45-degree field of view: 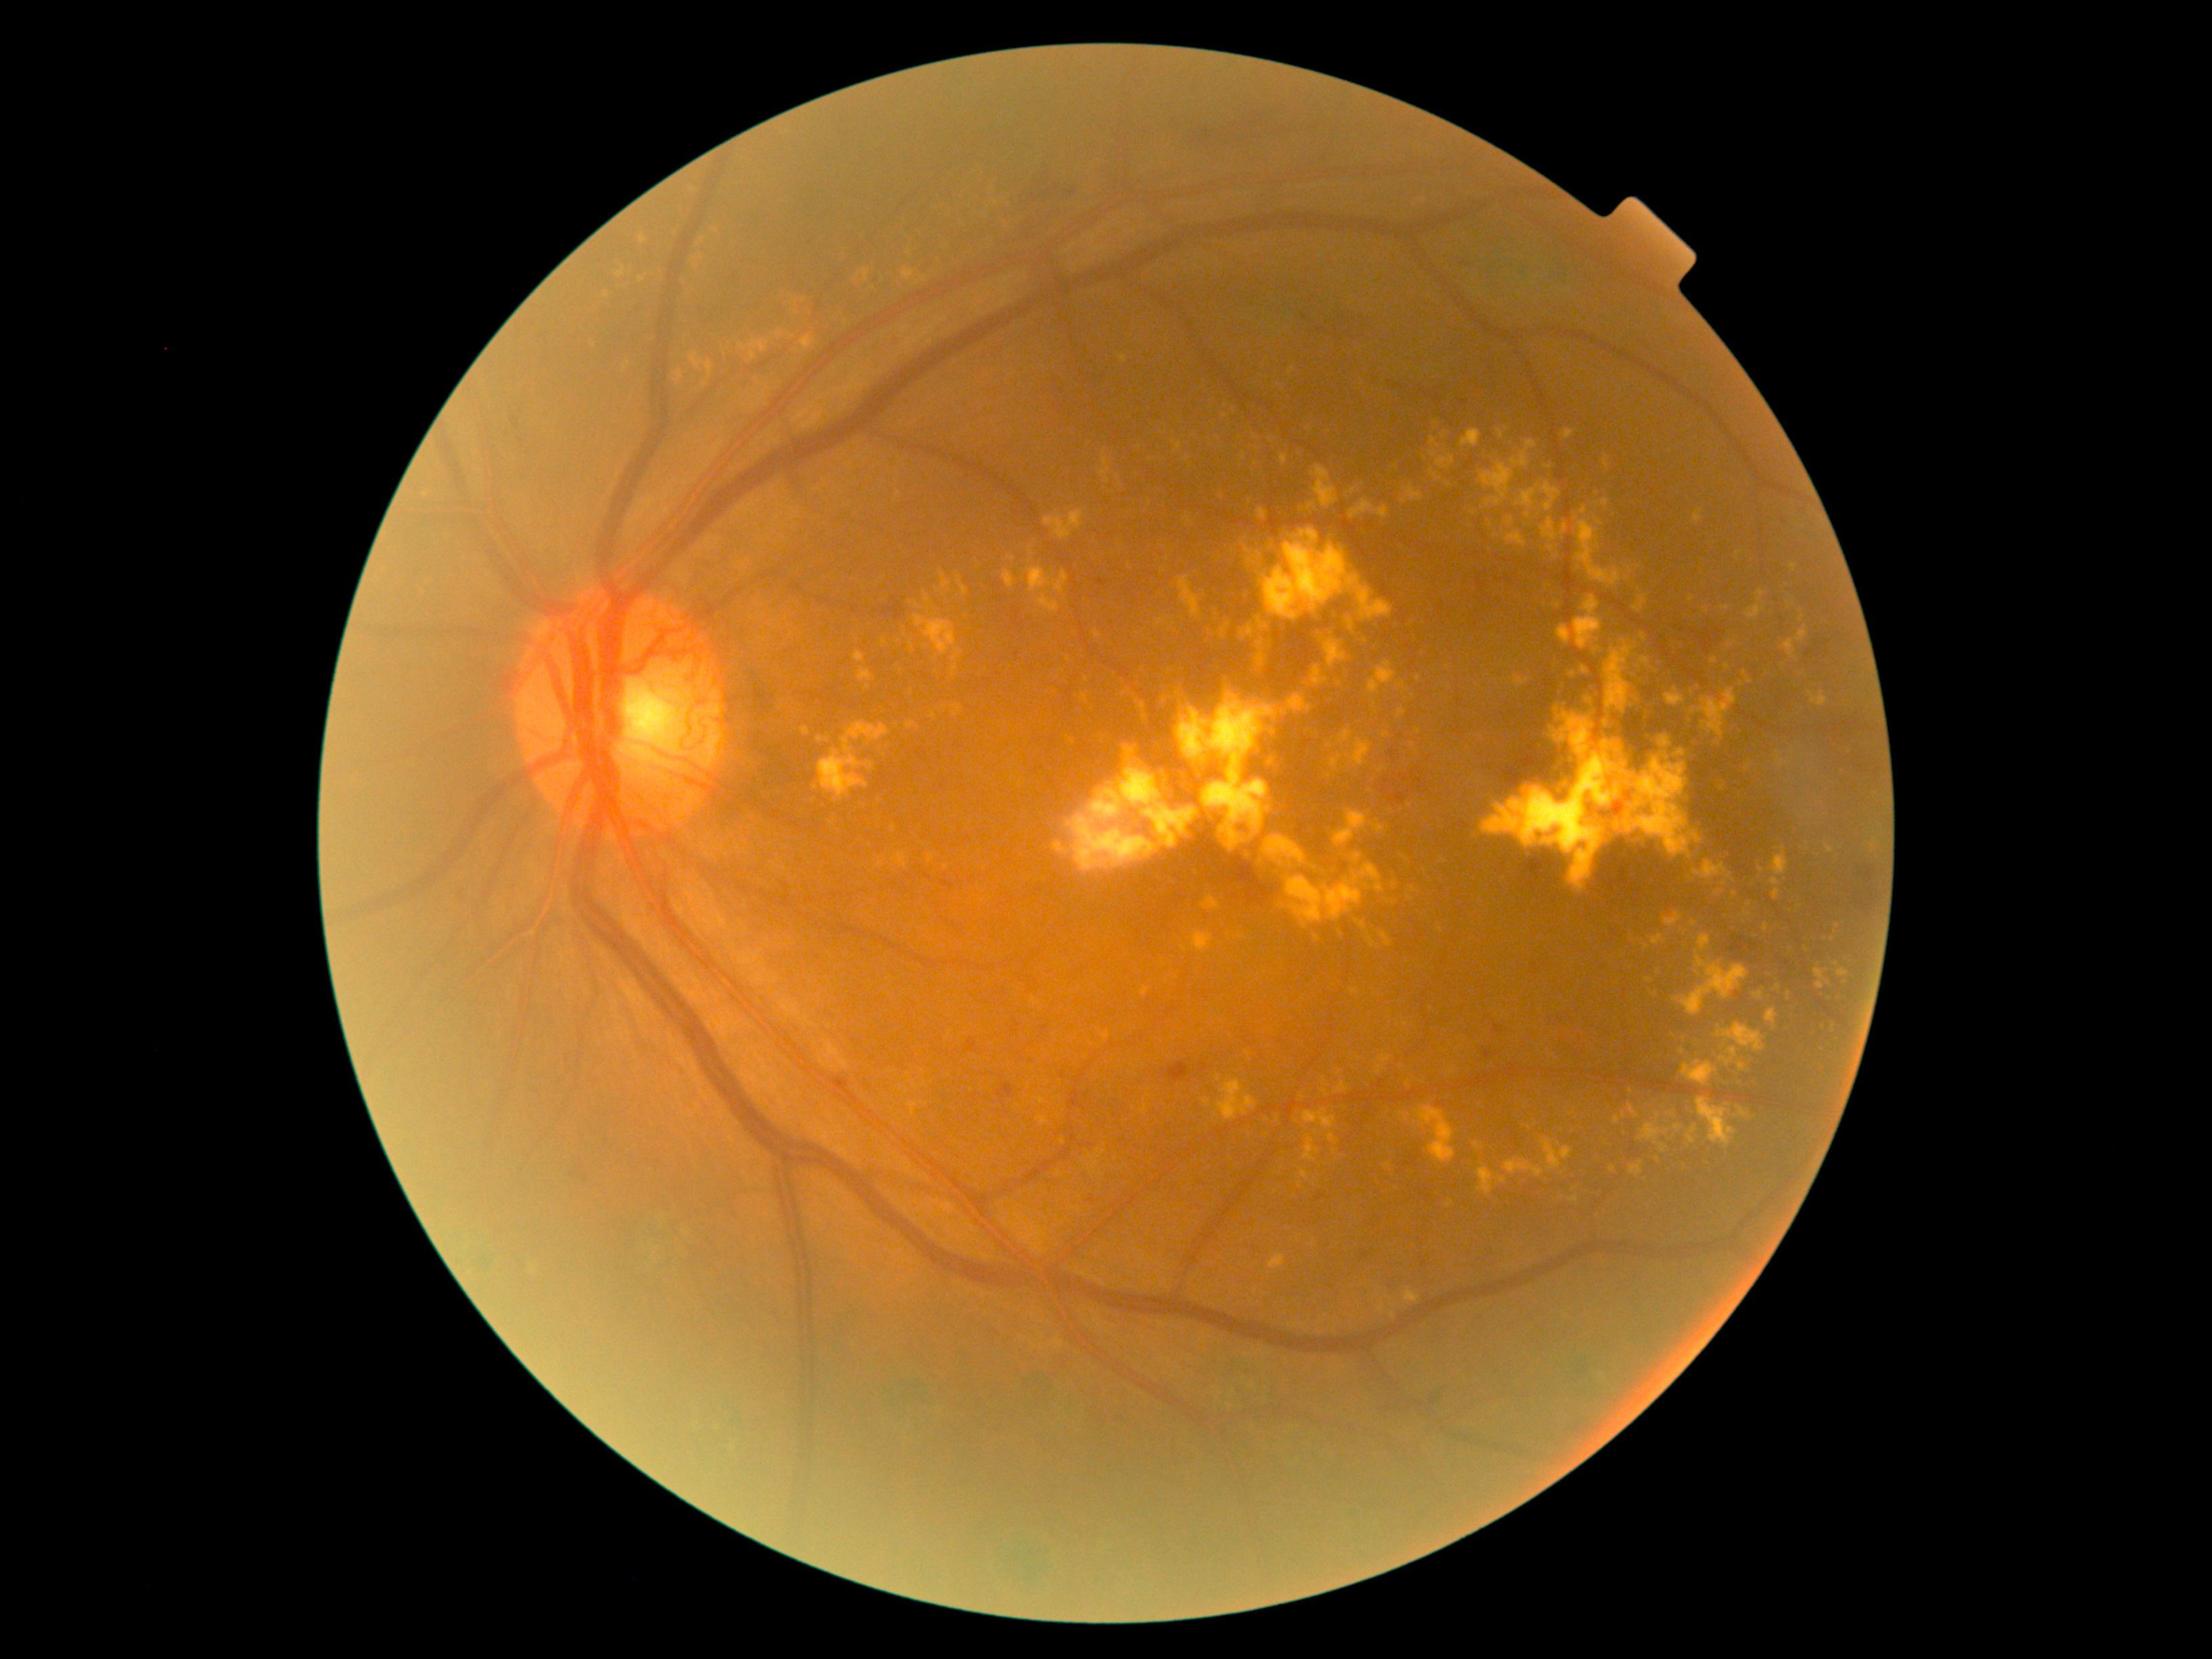
partial: true
dr_grade: 4
dr_grade_name: PDR
lesions:
  ex:
    - 1311 666 1329 688
    - 952 705 963 715
    - 1677 1166 1685 1177
    - 1329 1132 1340 1145
    - 1187 514 1192 524
    - 1067 737 1076 745
    - 1481 457 1516 508
    - 1505 1160 1544 1179
    - 1634 597 1649 613
    - 1138 757 1143 768
    - 1652 935 1666 947
    - 1280 905 1288 910
  ex_small:
    - pt(1659, 972)
    - pt(979, 566)
    - pt(1806, 948)
    - pt(1187, 459)
    - pt(1795, 567)
    - pt(1260, 672)
    - pt(1719, 744)
    - pt(1631, 1092)